Fundus photo: 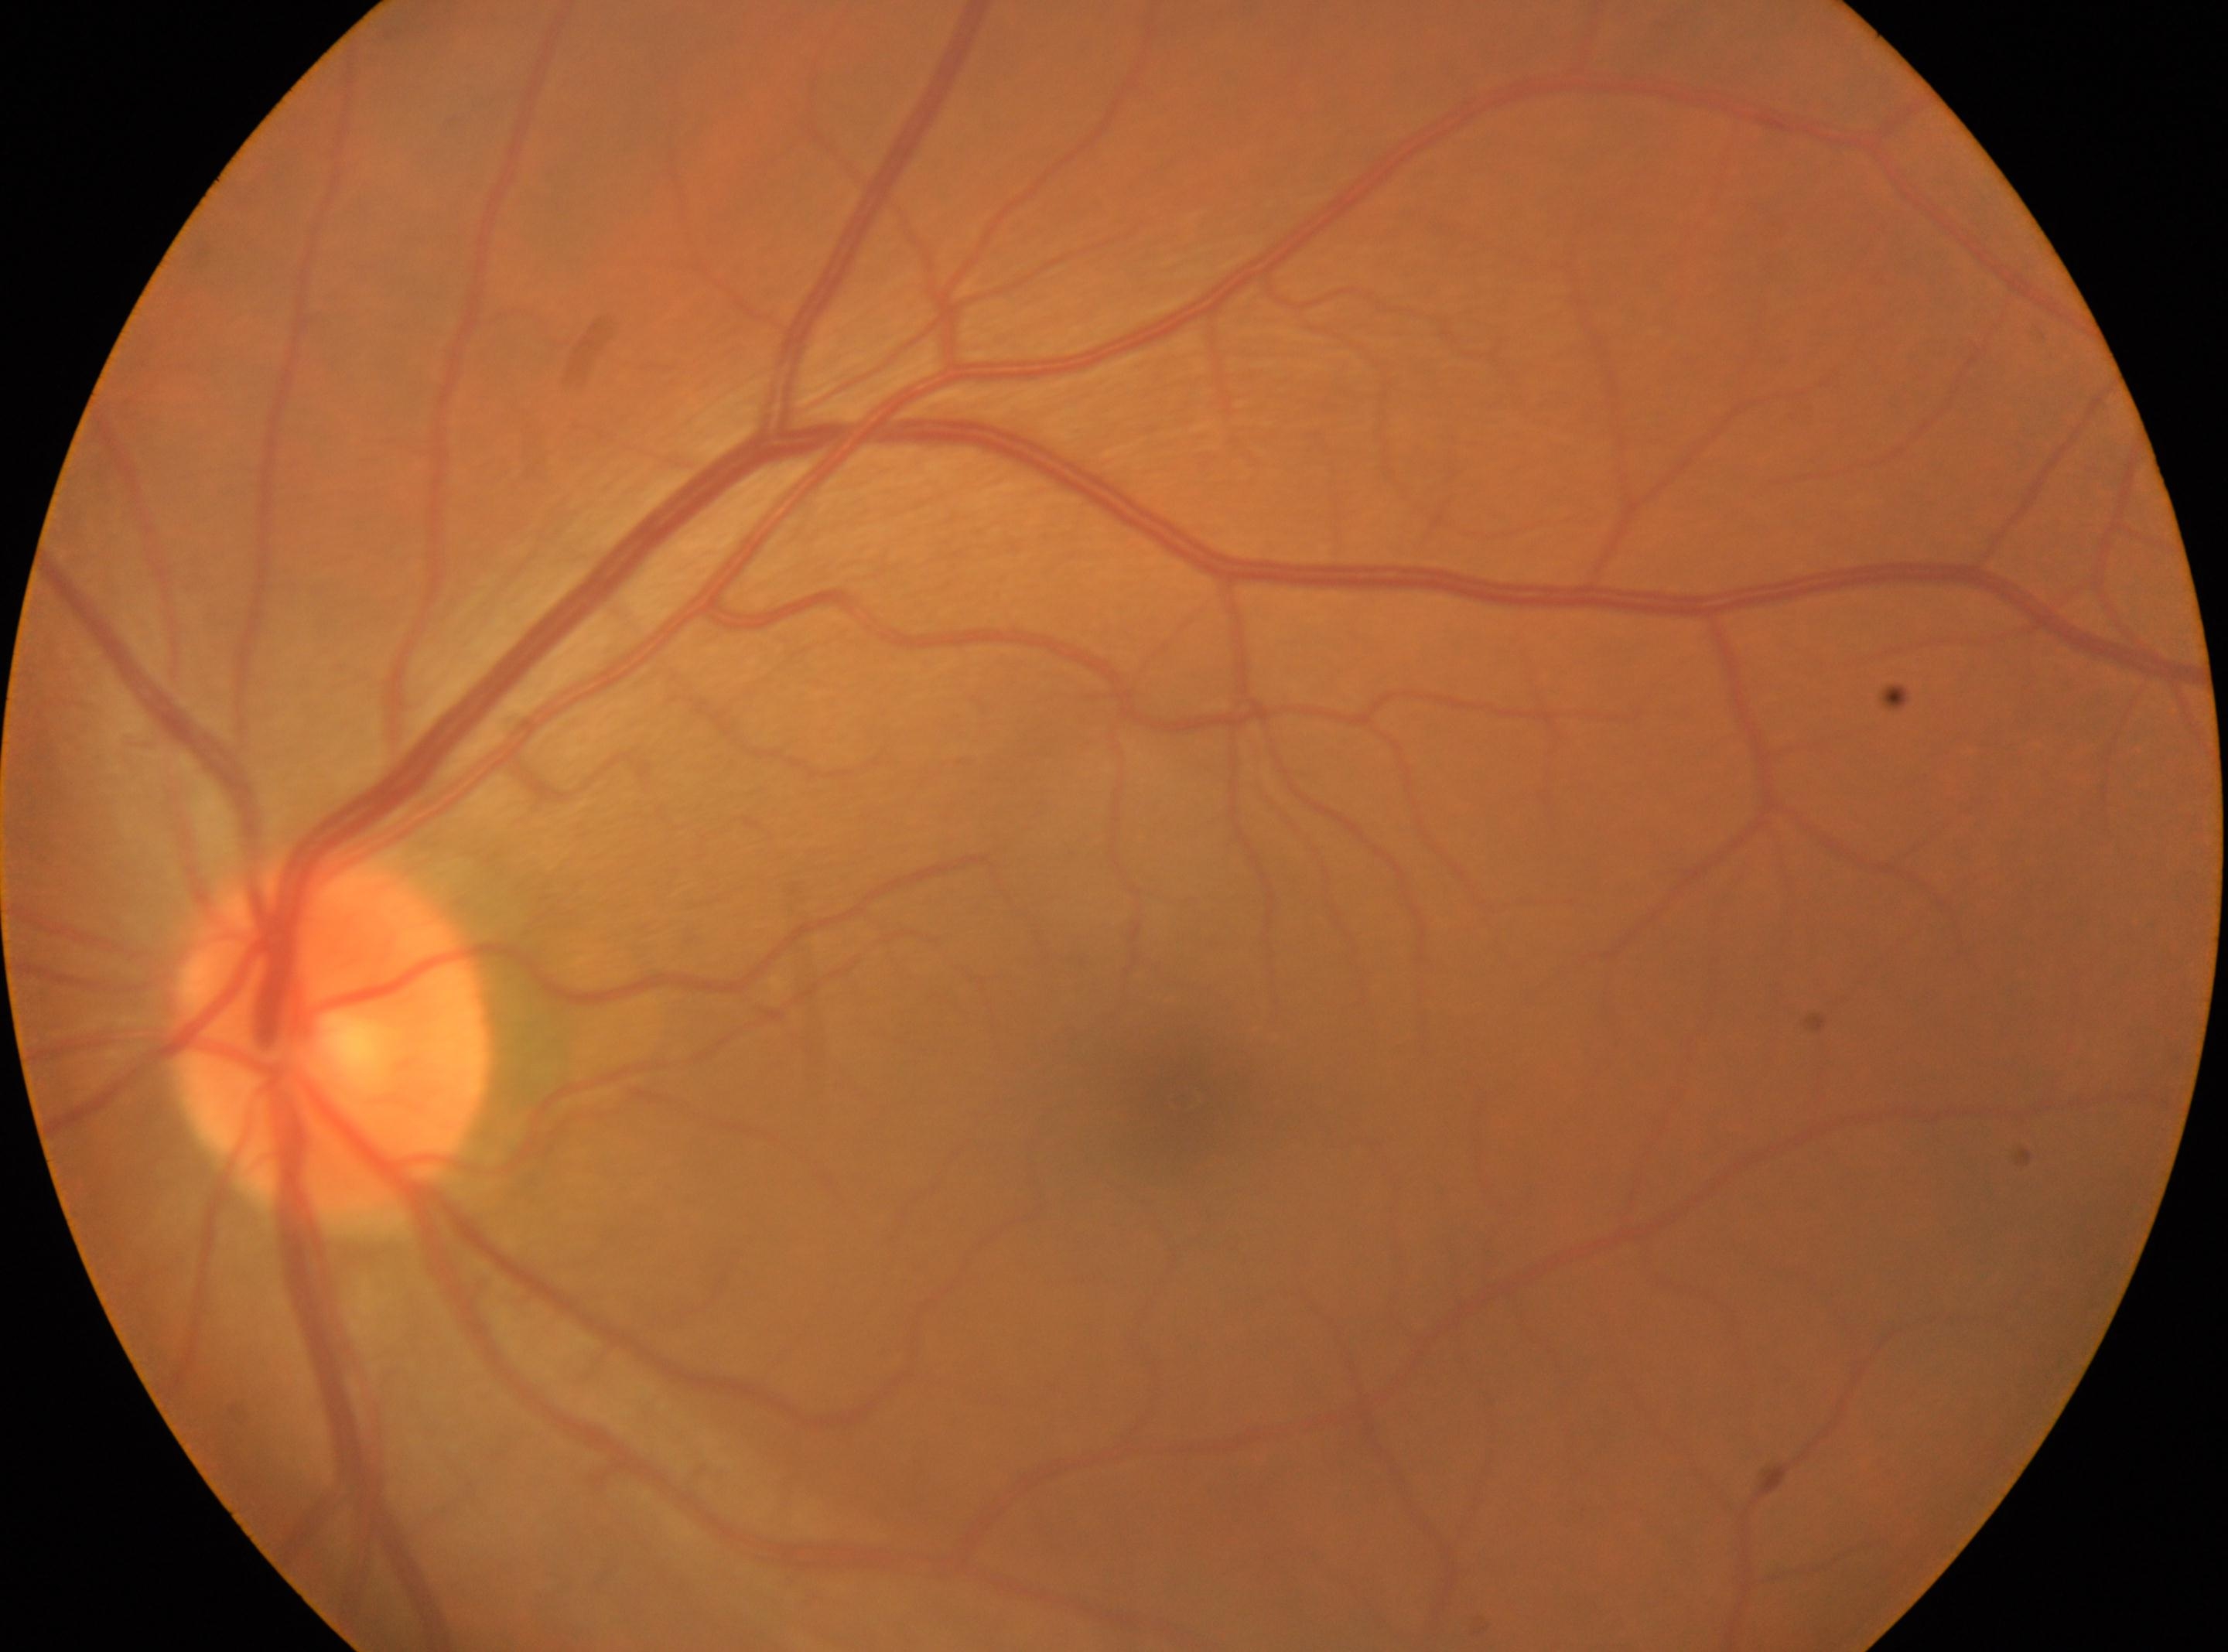 Q: Optic disc center?
A: x=331, y=1038
Q: Locate the fovea.
A: x=1184, y=1098
Q: What is the laterality?
A: left eye
Q: DR stage?
A: grade 0
Q: Any diabetic retinopathy?
A: No DR findings